Without pupil dilation — 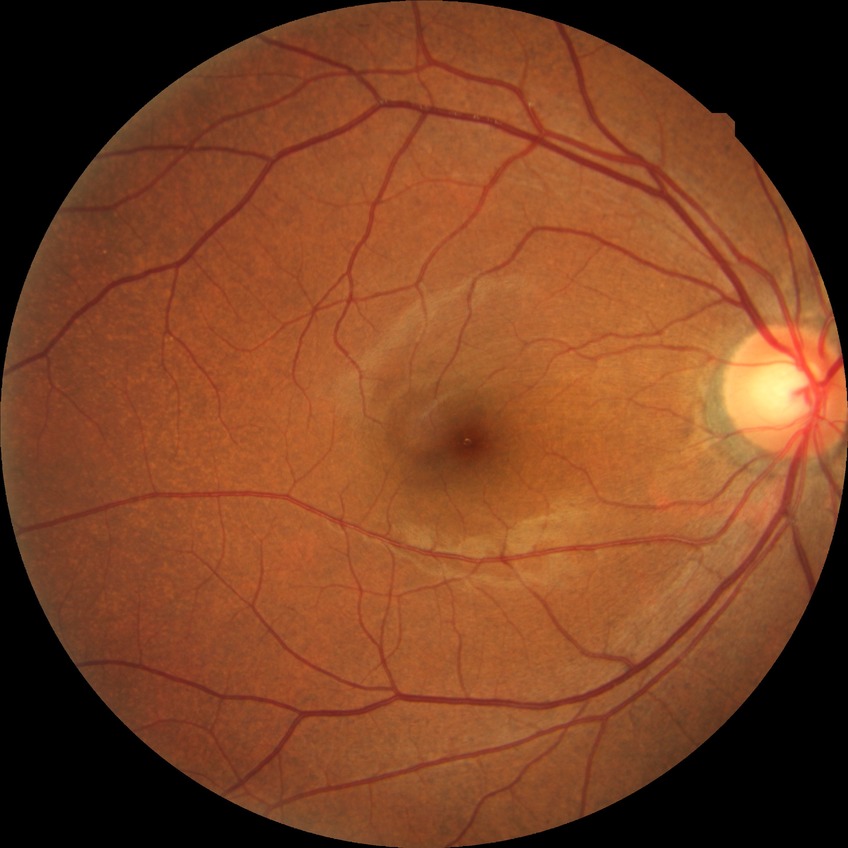

Diabetic retinopathy (DR): NDR (no diabetic retinopathy).